Diabetic retinopathy graded by the modified Davis classification: 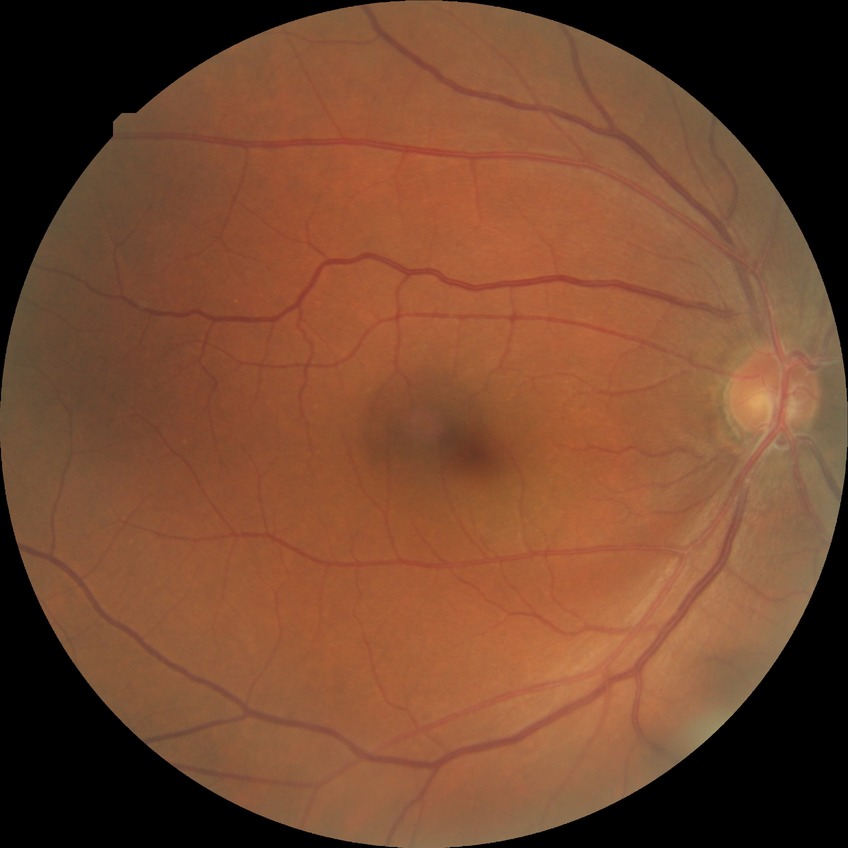

Davis grading is no diabetic retinopathy.